Acquired with a Forus 3Nethra fundus camera:
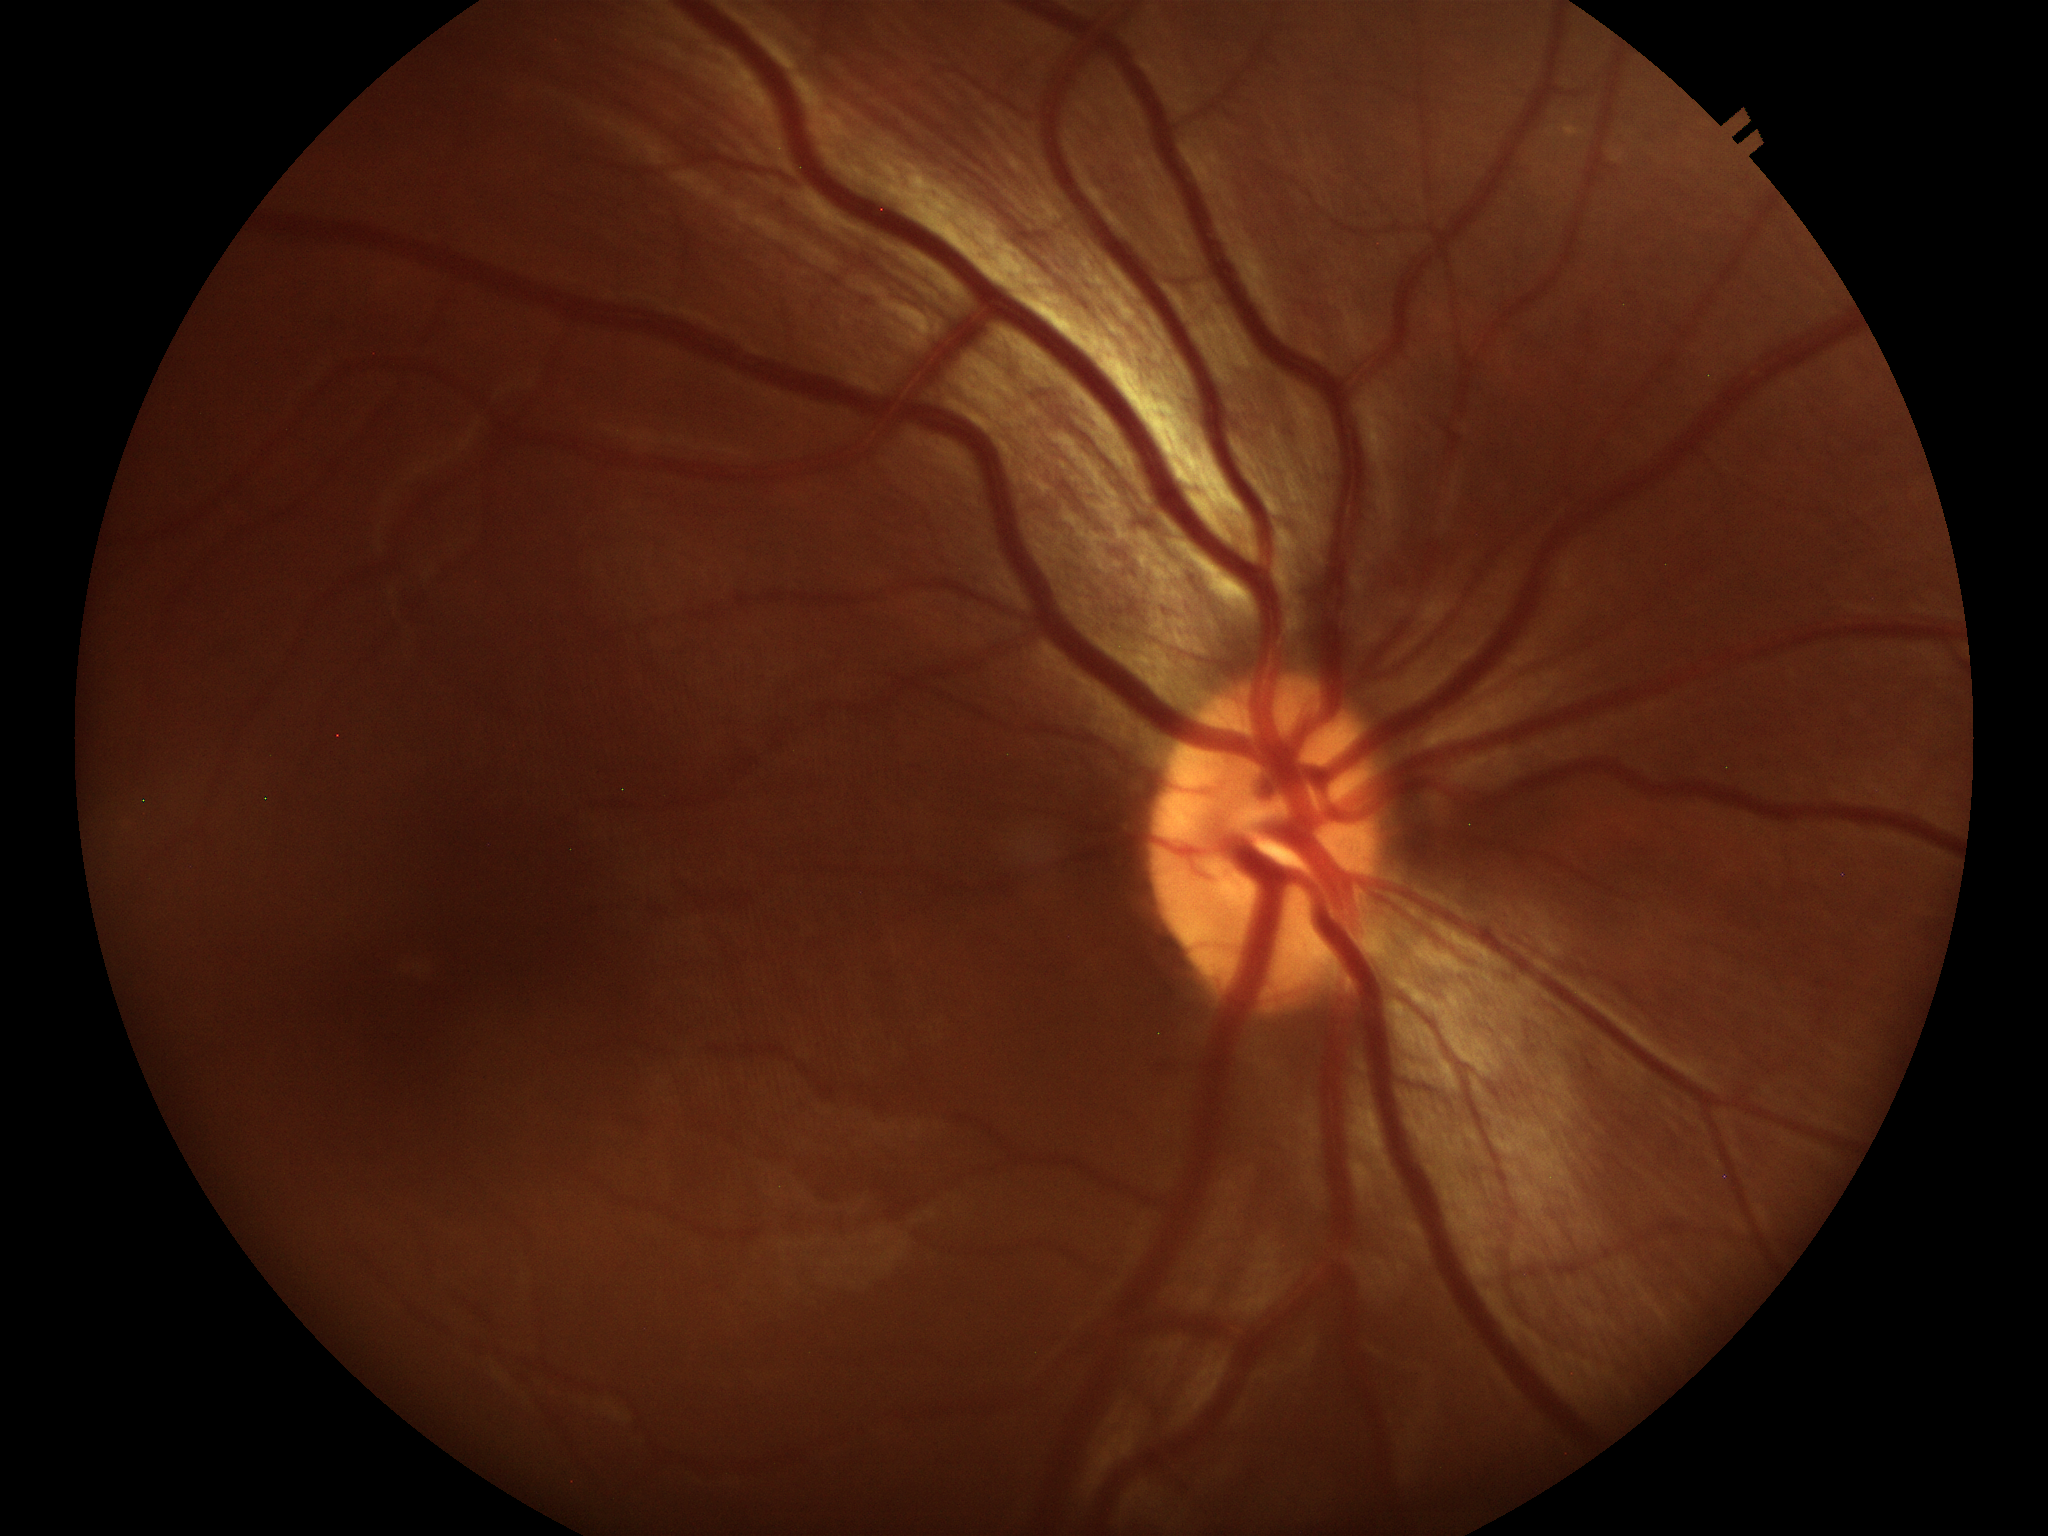
Vertical CDR (VCDR) of 0.42.
No signs of glaucoma.